1240 by 1240 pixels. Wide-field fundus photograph of an infant. Acquired on the Phoenix ICON
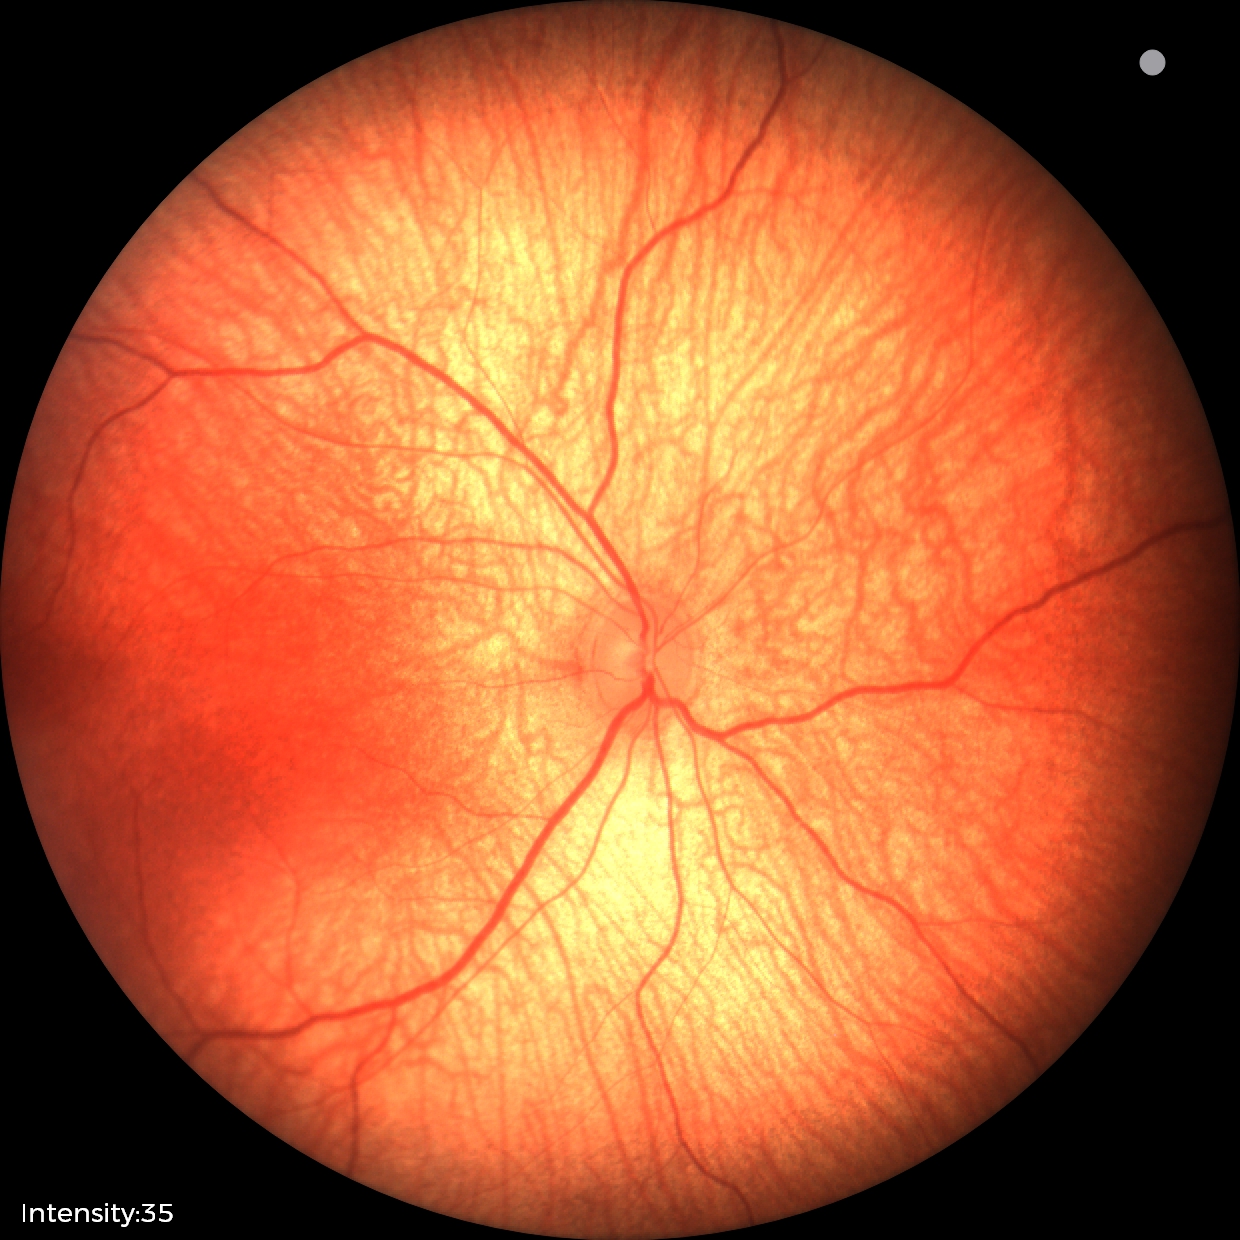
Diagnosis: normal retinal appearance